FOV: 45 degrees — 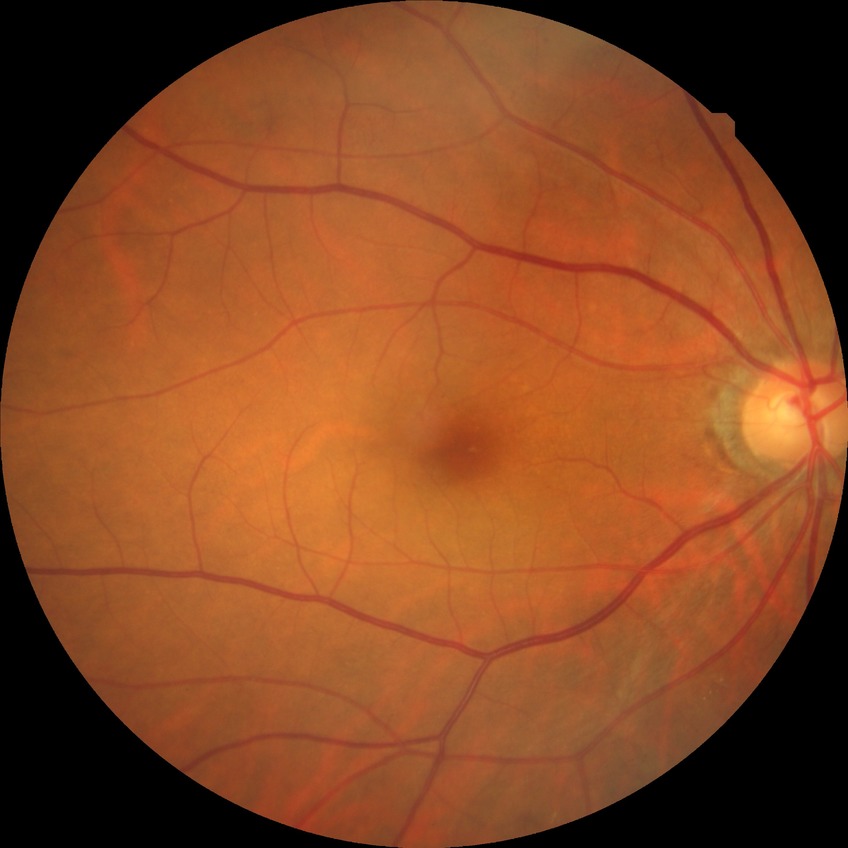
retinopathy stage=no diabetic retinopathy.